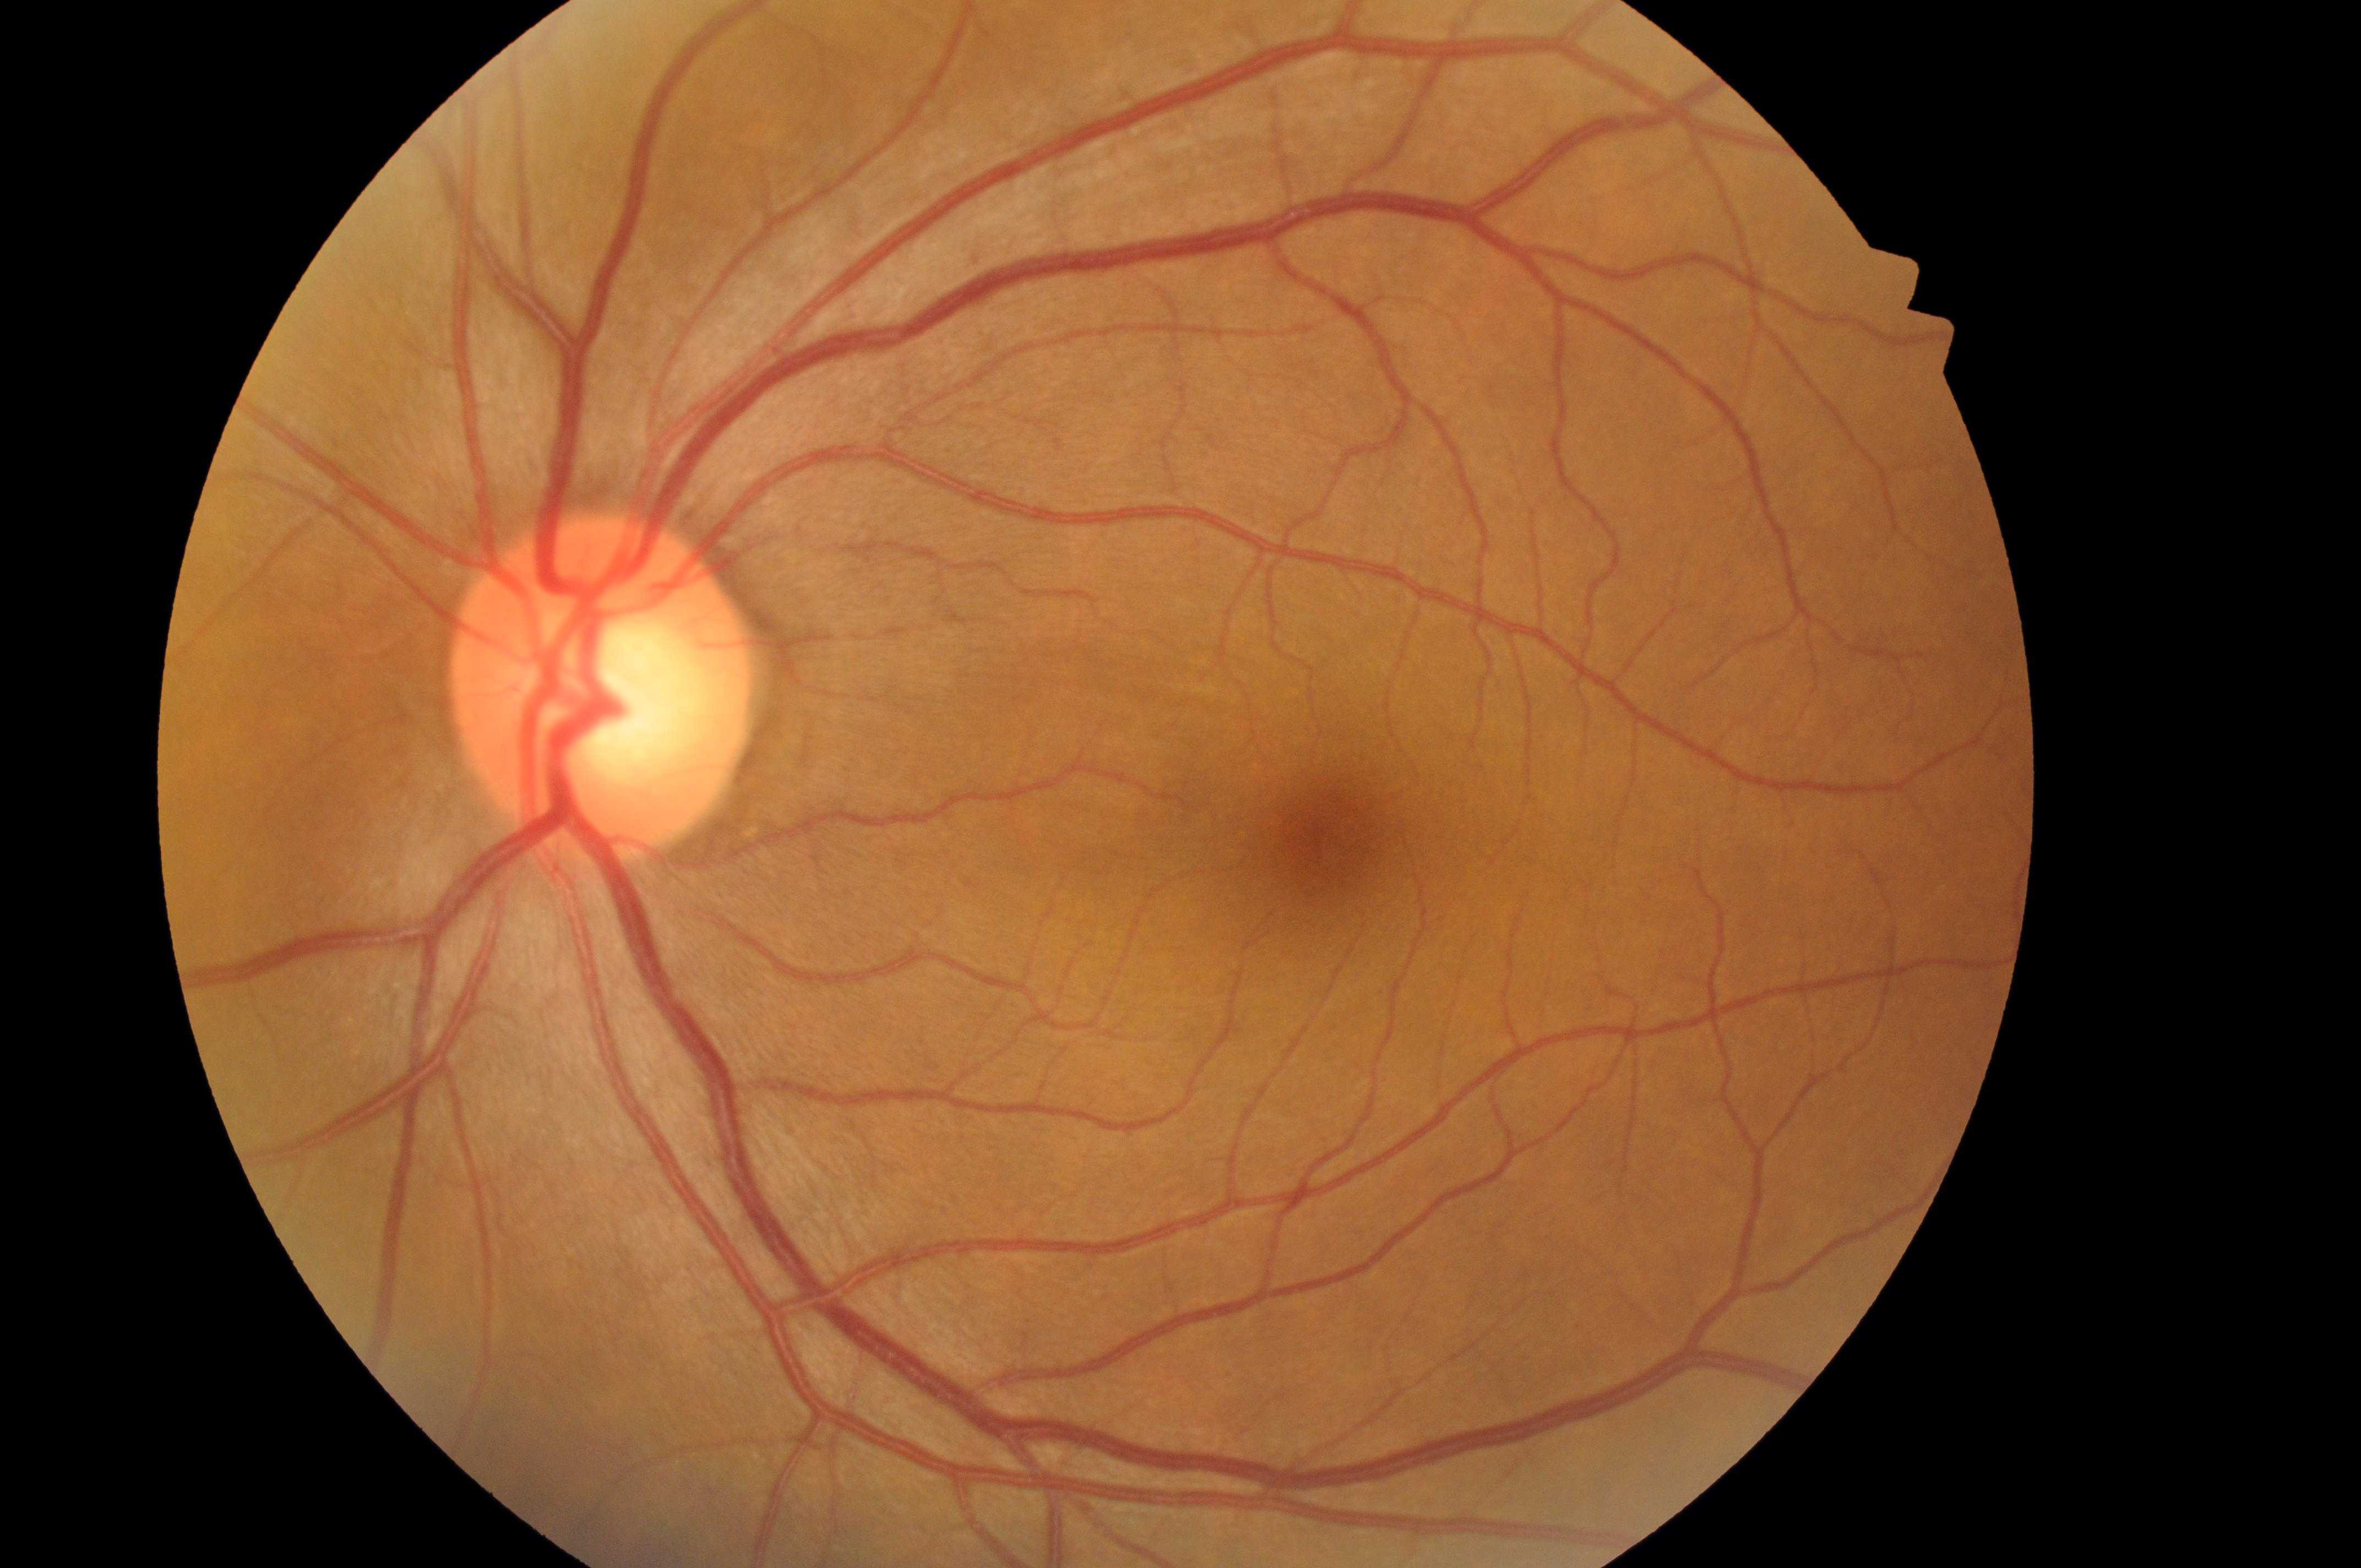
Imaged eye: left.
The ONH is at (596,701).
Retinopathy grade is no apparent retinopathy (0).
The fovea centralis is at (1328,839).
Macular edema: grade 0 (no risk).